Pediatric wide-field fundus photograph · 1440x1080: 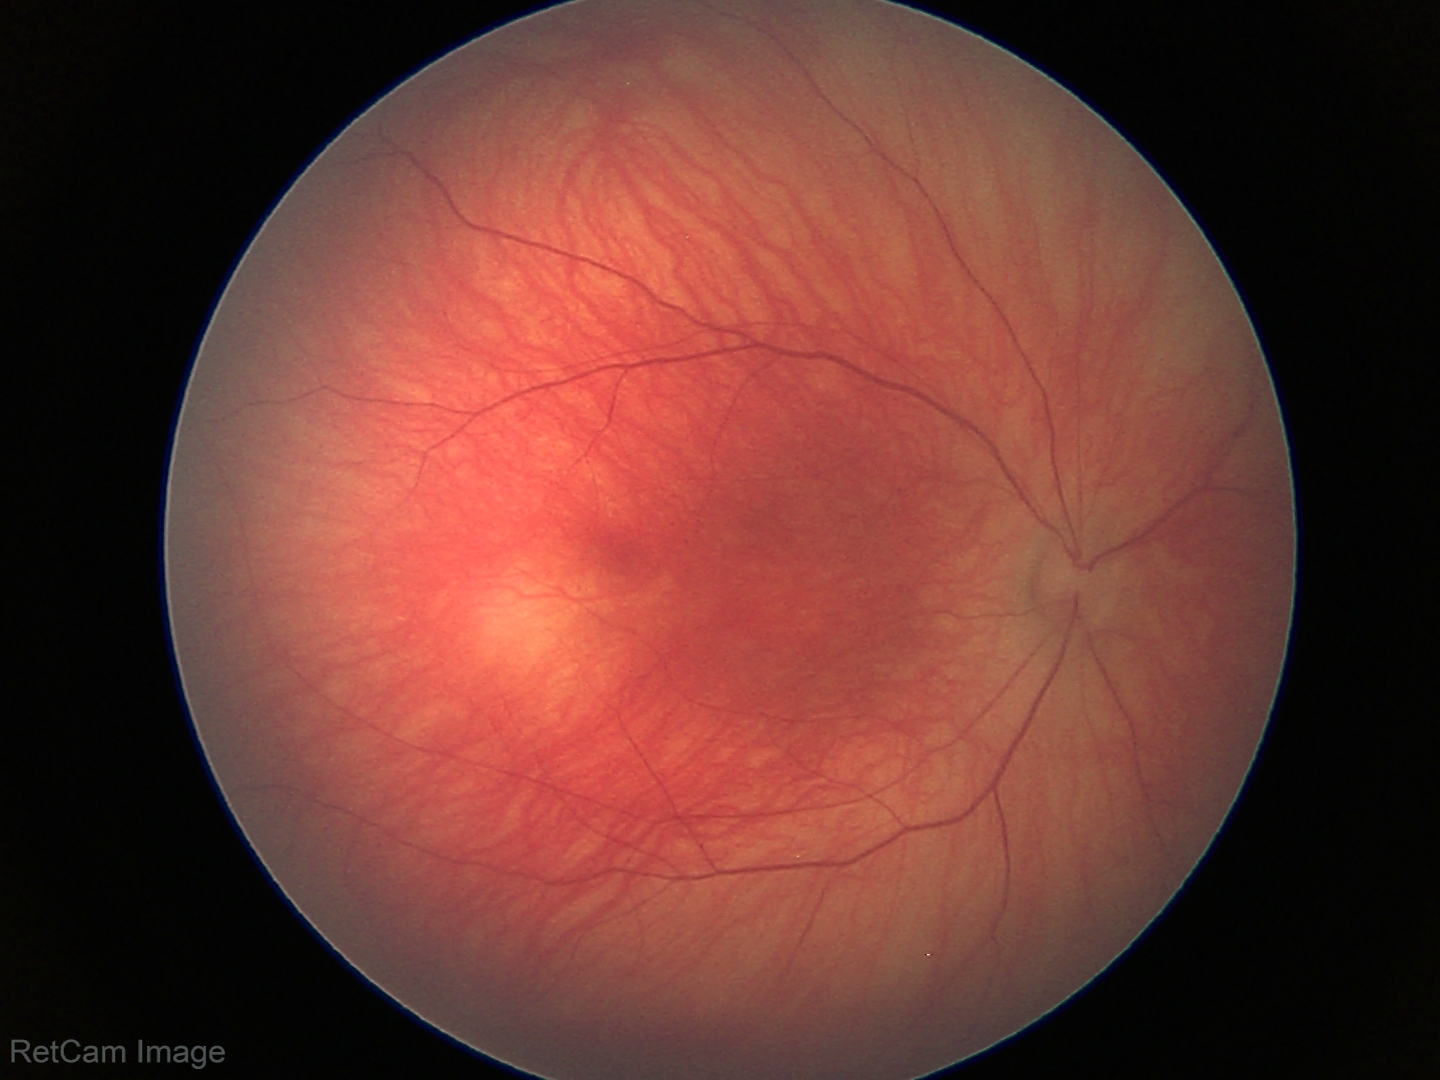

Examination with physiological retinal findings.